No pharmacologic dilation
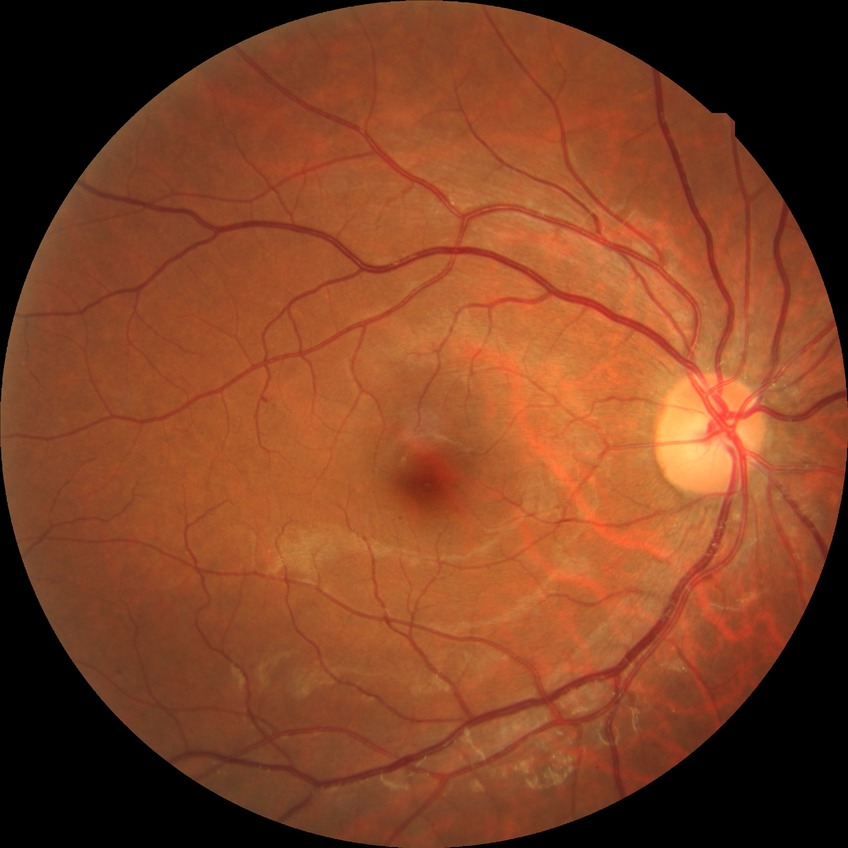 Disease class: non-proliferative diabetic retinopathy.
Diabetic retinopathy (DR): SDR (simple diabetic retinopathy).